45° field of view.
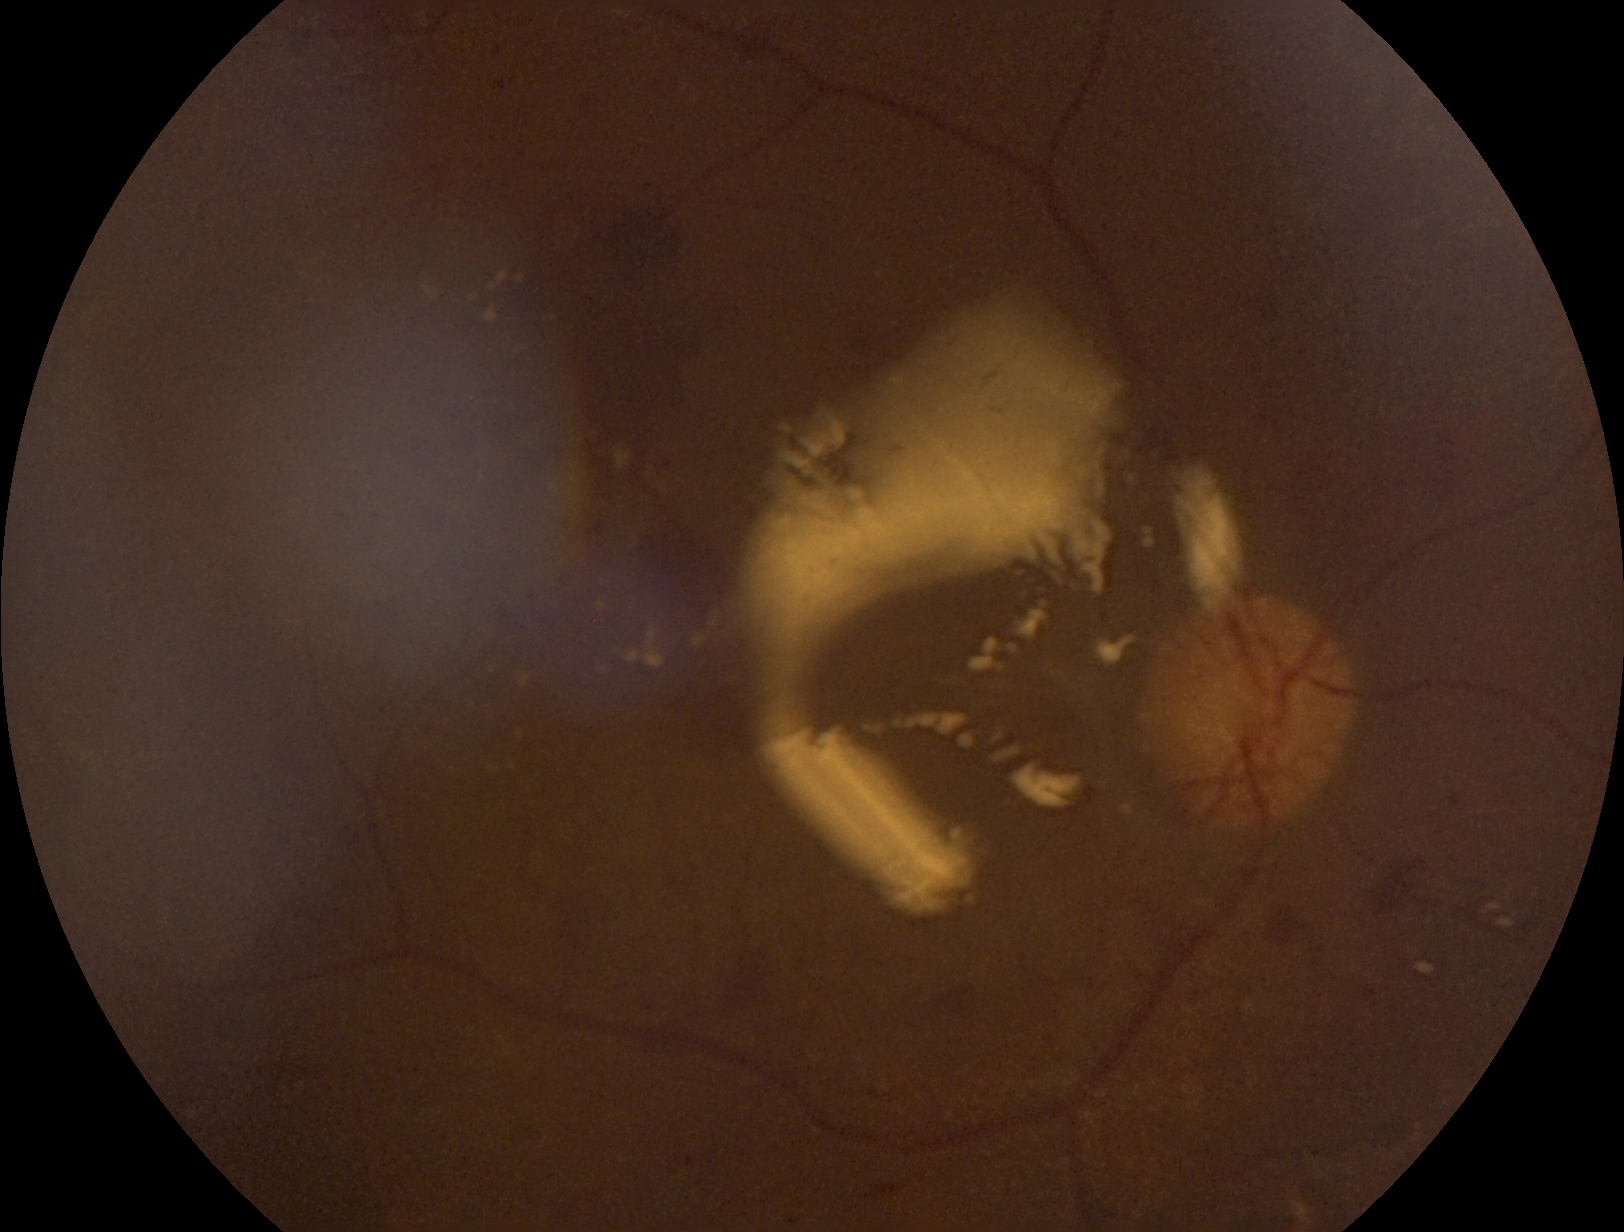
Retinopathy: 4/4.
DR class: proliferative diabetic retinopathy.